512x512:
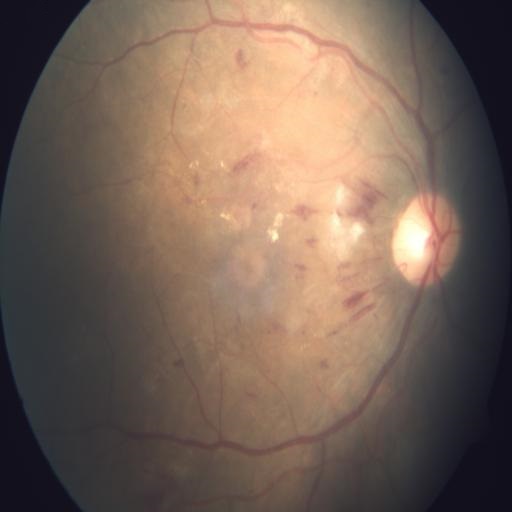

Abnormalities:
- hemorrhagic retinopathy